45-degree field of view, color fundus image, camera: NIDEK AFC-230: 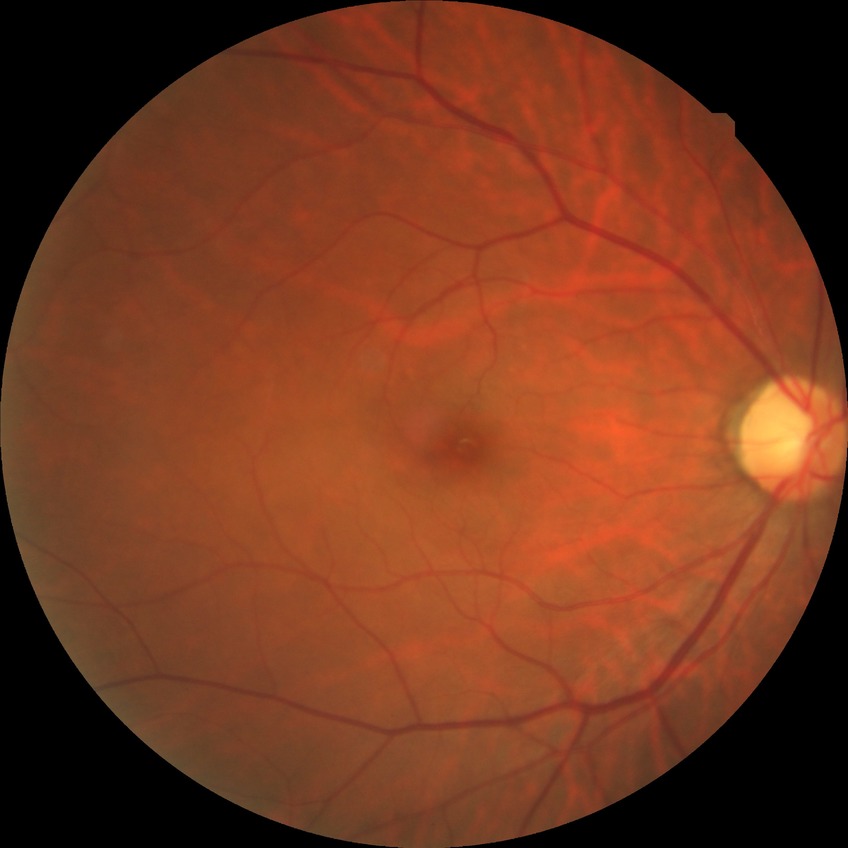

retinopathy stage: no diabetic retinopathy